1440 by 1080 pixels. 130° field of view (Natus RetCam Envision). Wide-field fundus photograph of an infant
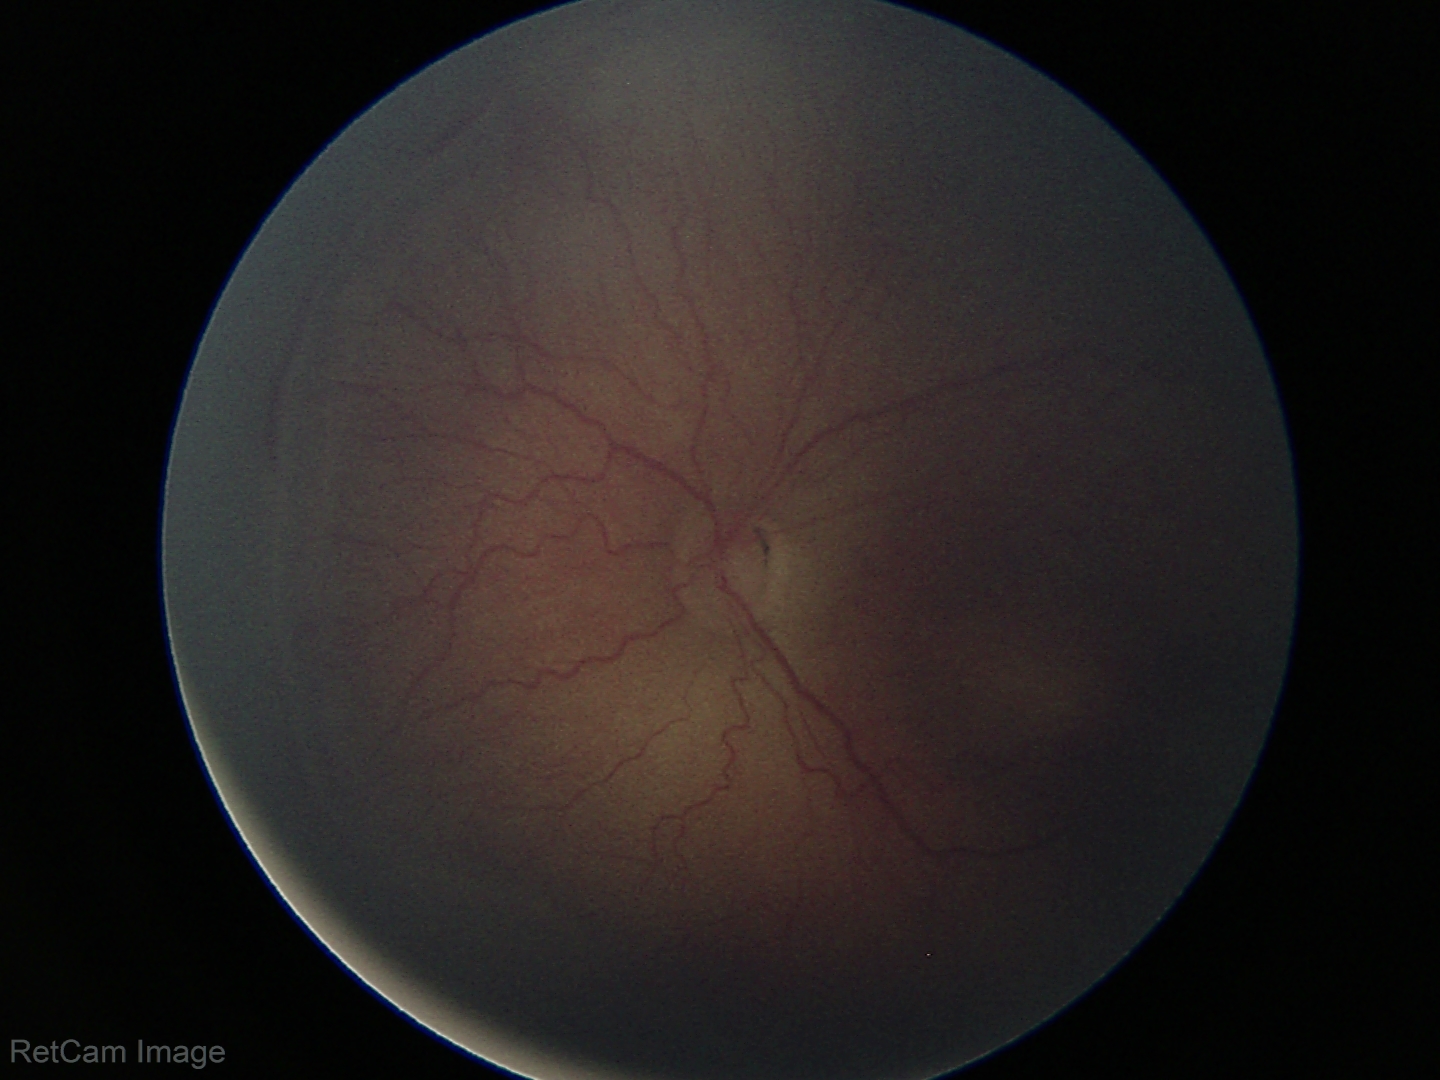
ROP grade: stage 2.